2212x1678px.
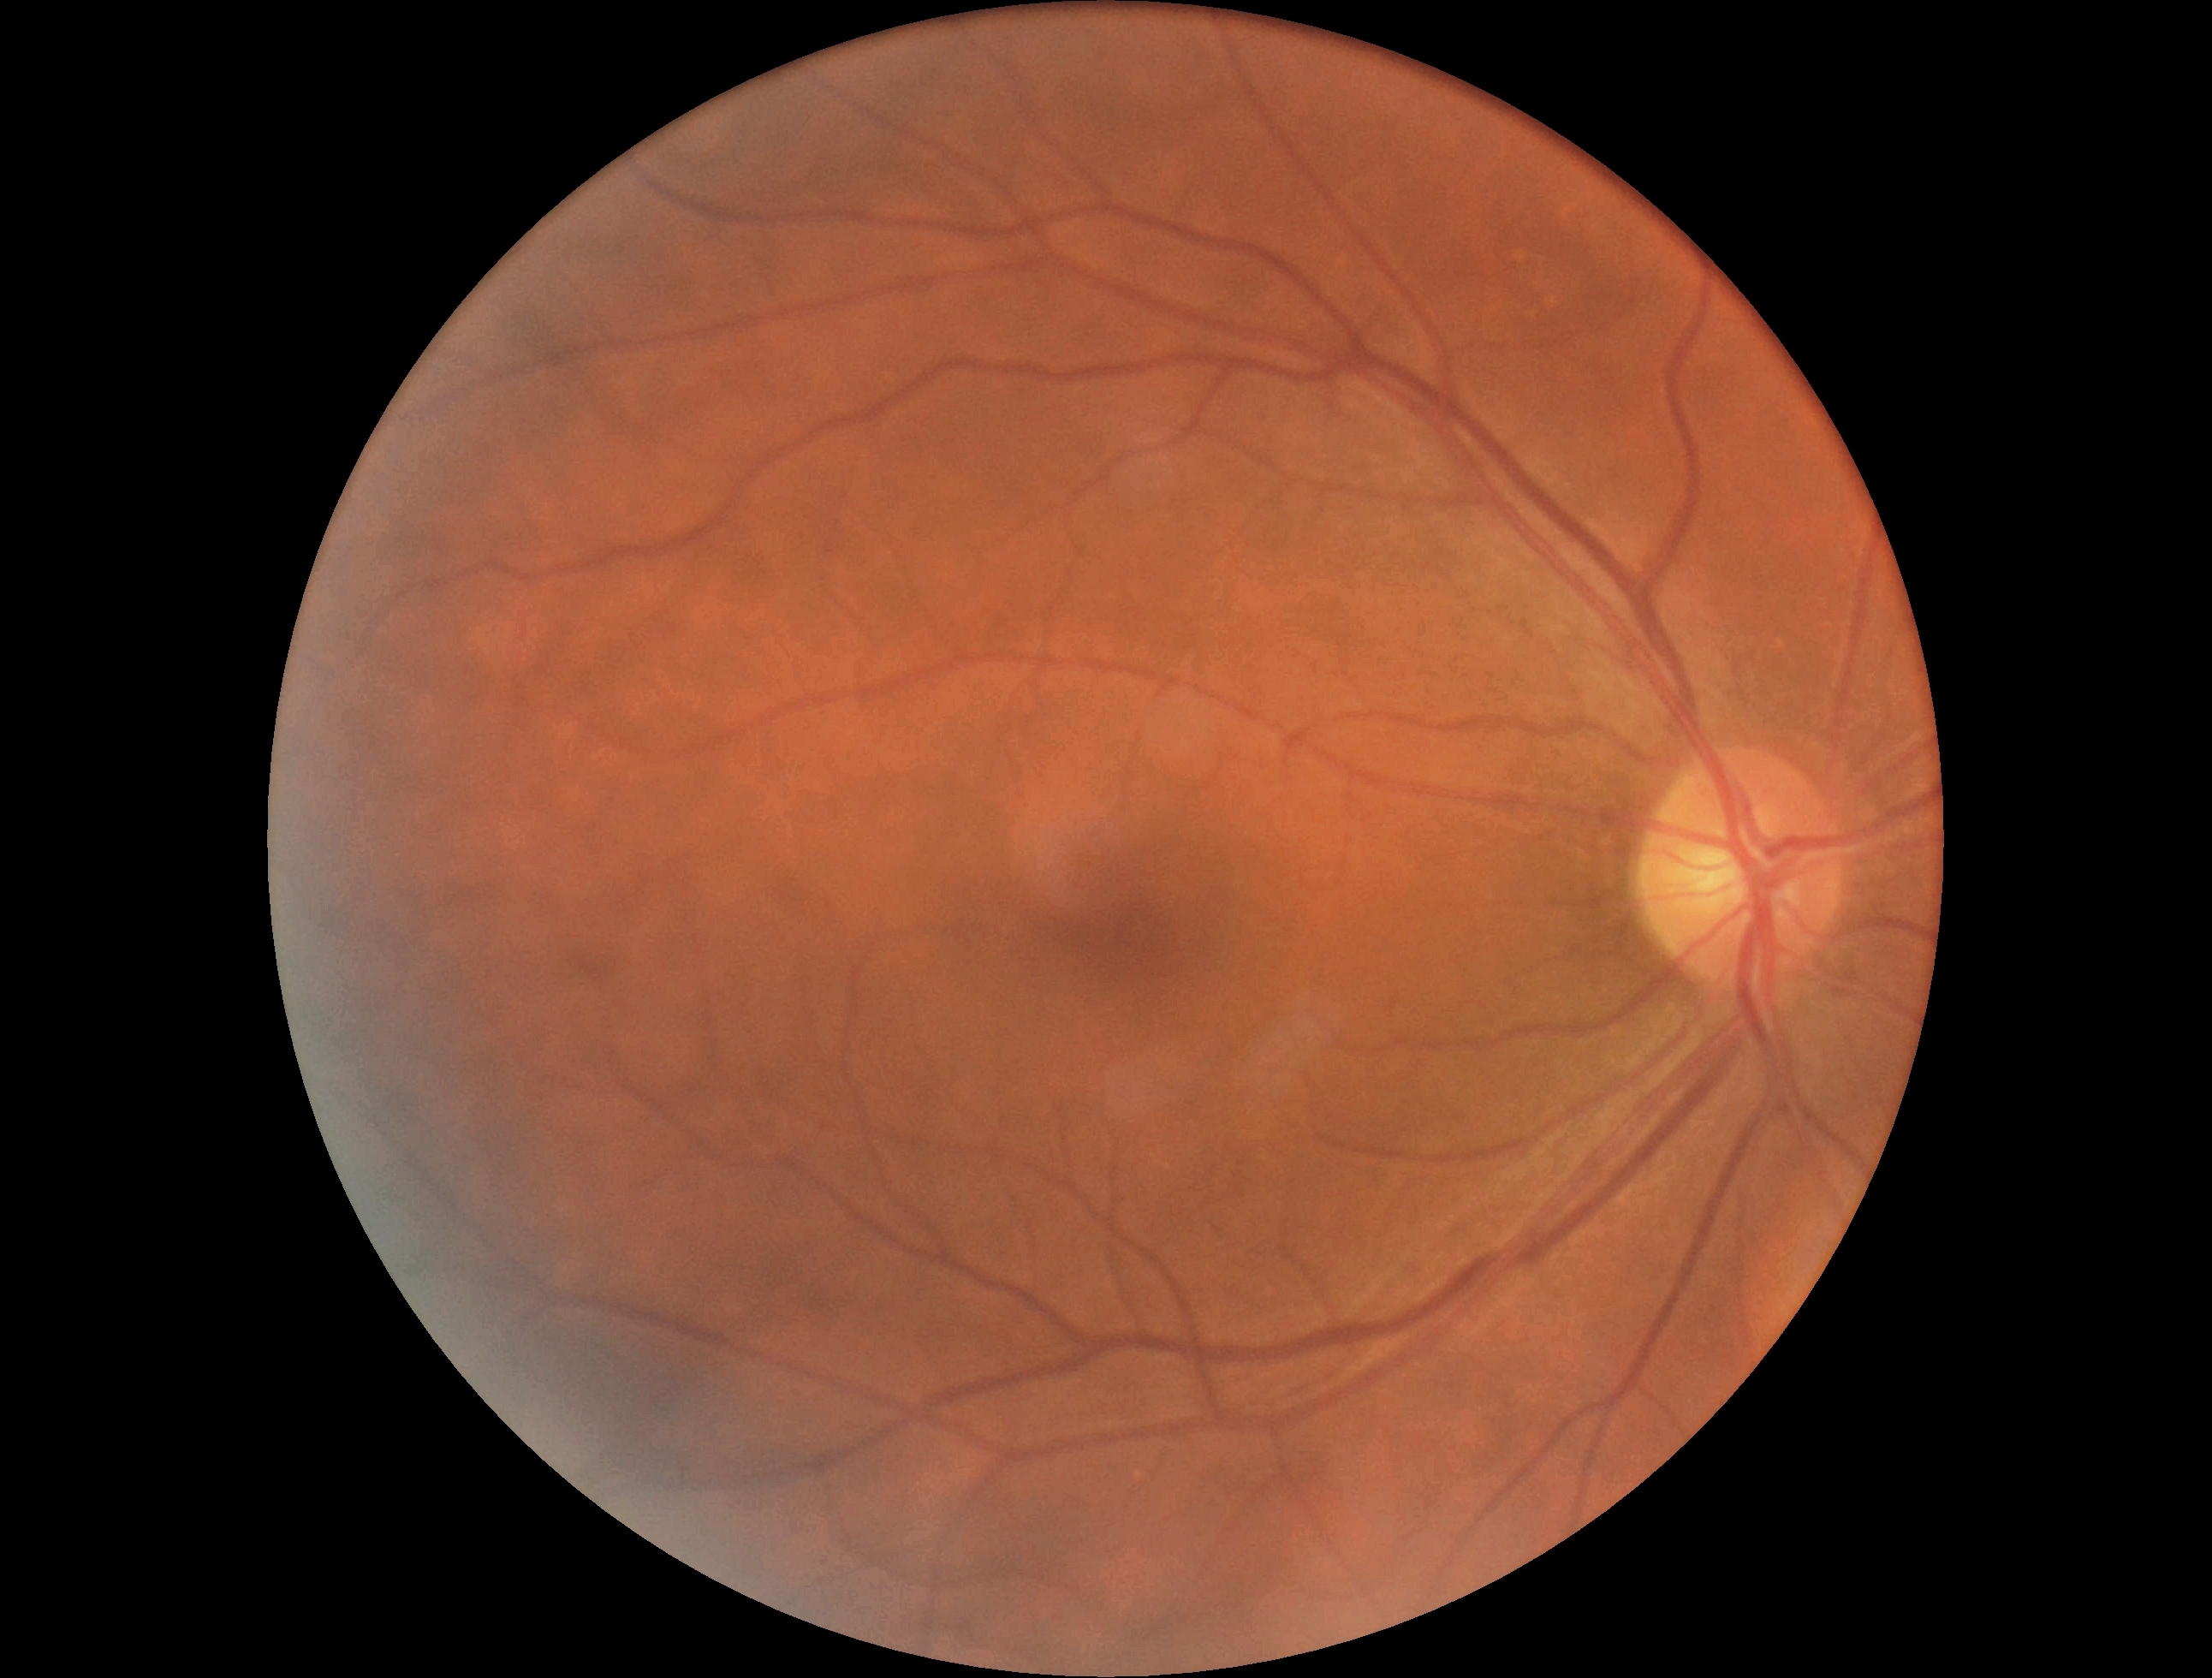
retinopathy: grade 0 (no apparent retinopathy).